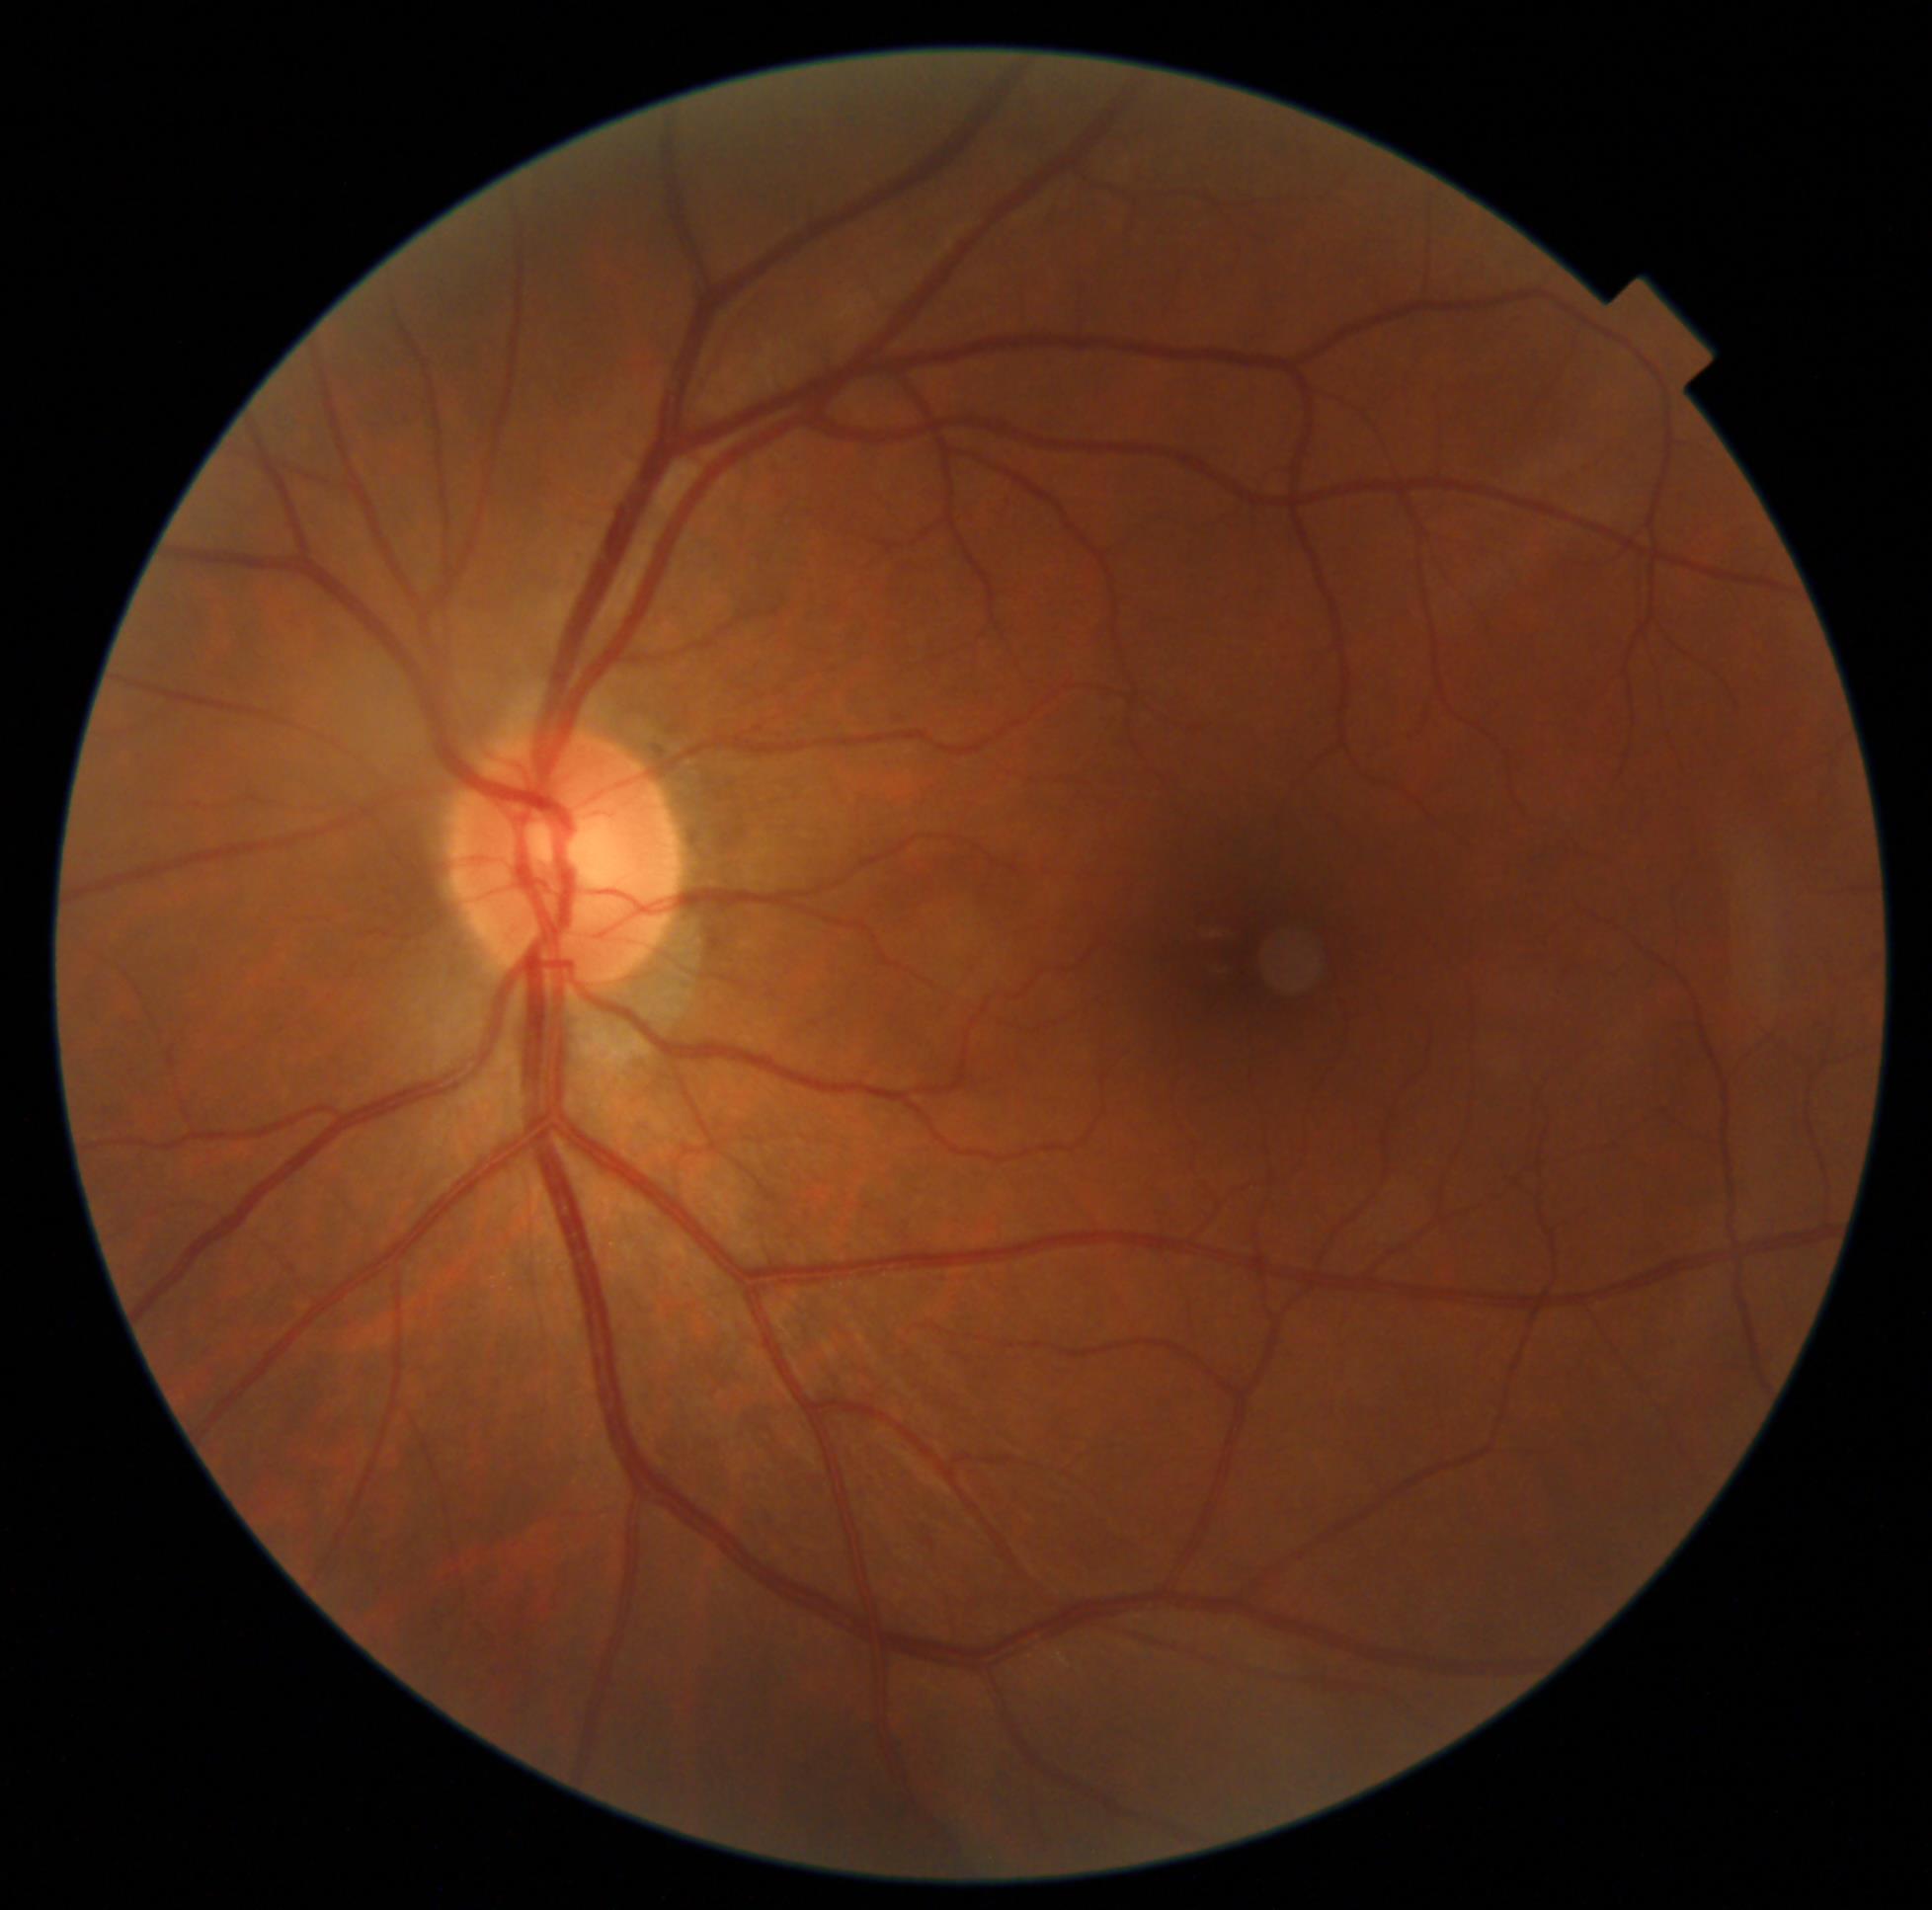
DR=no apparent diabetic retinopathy (grade 0), DR impression=no signs of DR.